Posterior pole photograph, camera: NIDEK AFC-230, without pupil dilation:
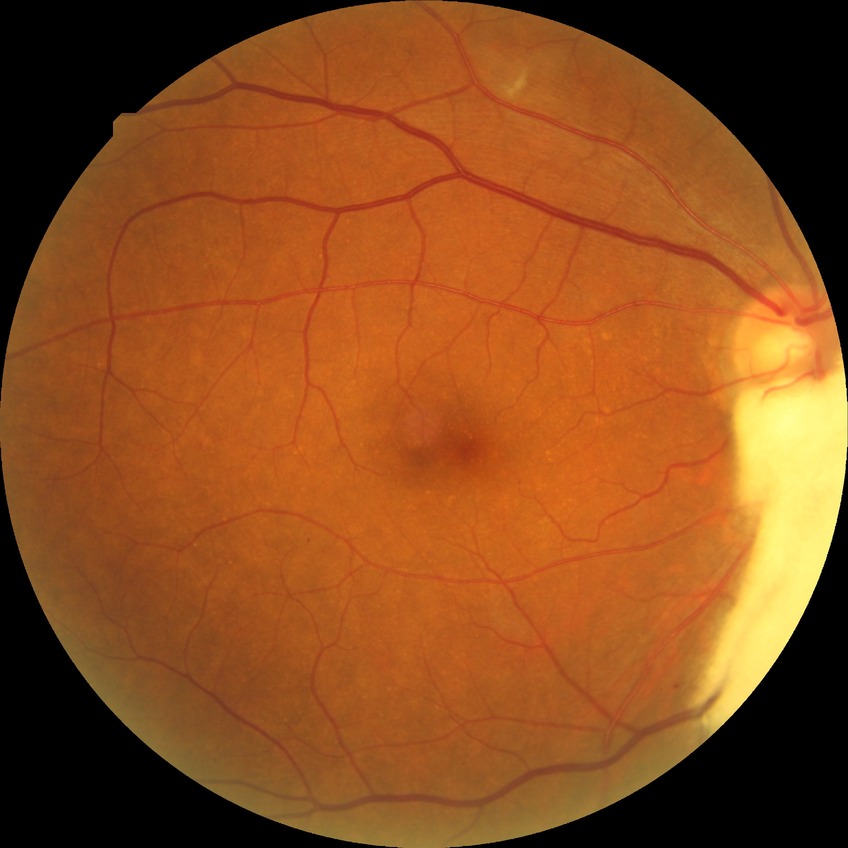
Diabetic retinopathy (DR): PPDR (pre-proliferative diabetic retinopathy).